Acquired on the Natus RetCam Envision · RetCam wide-field infant fundus image · image size 1440x1080: 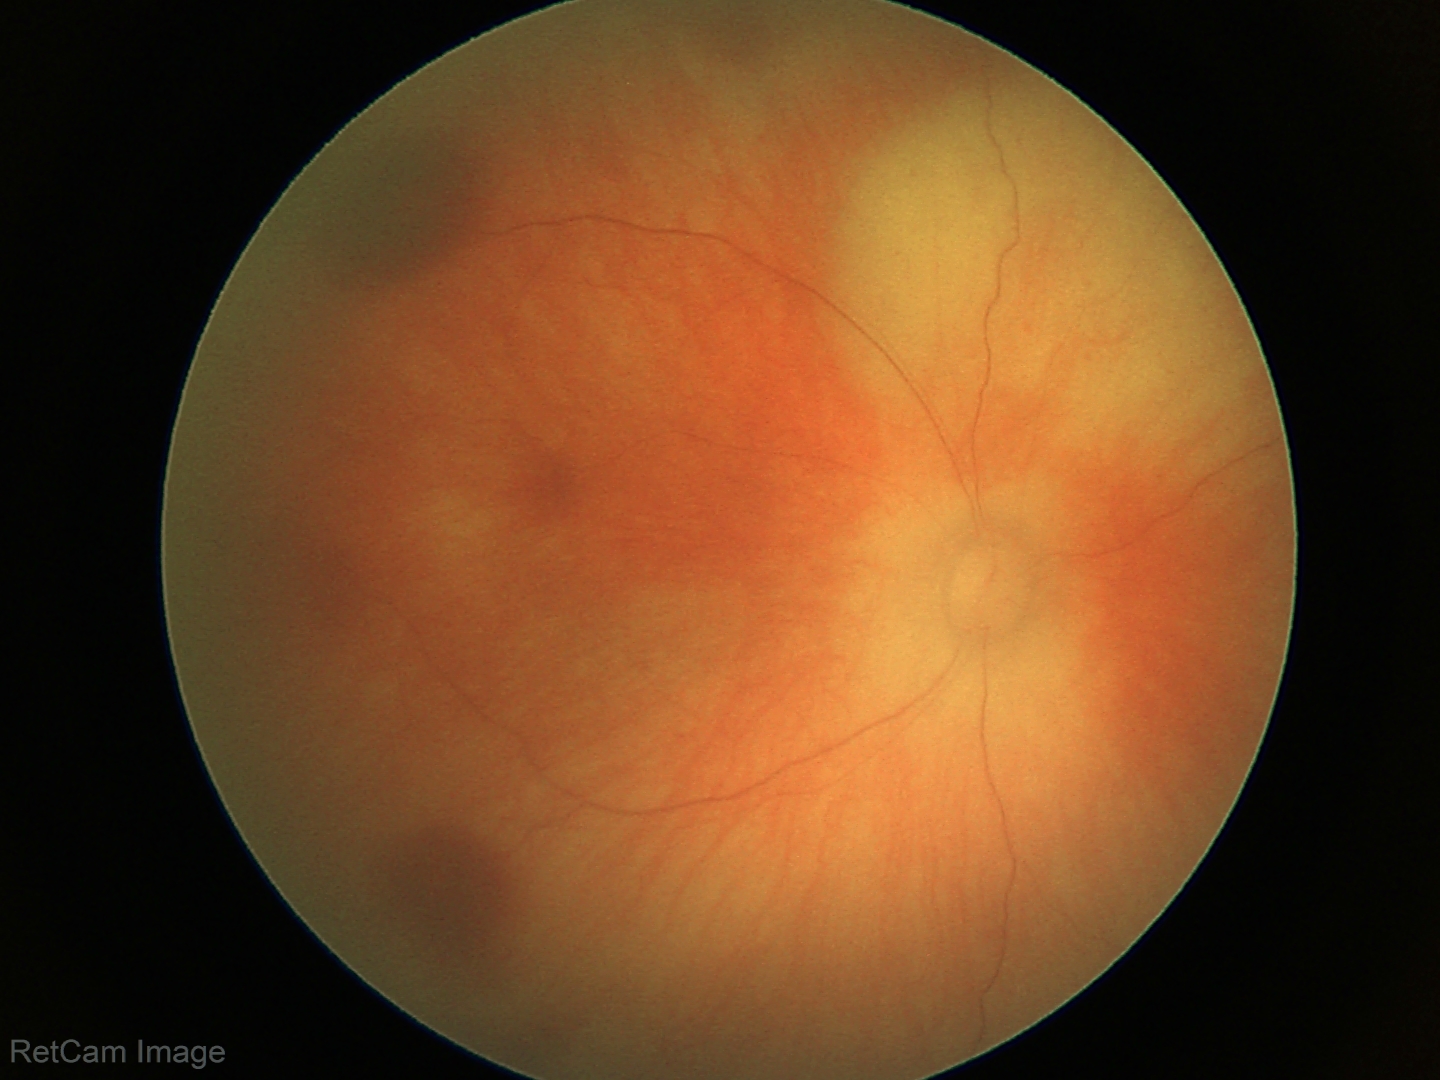

Series diagnosed as retinal hemorrhages.